Fundus photo
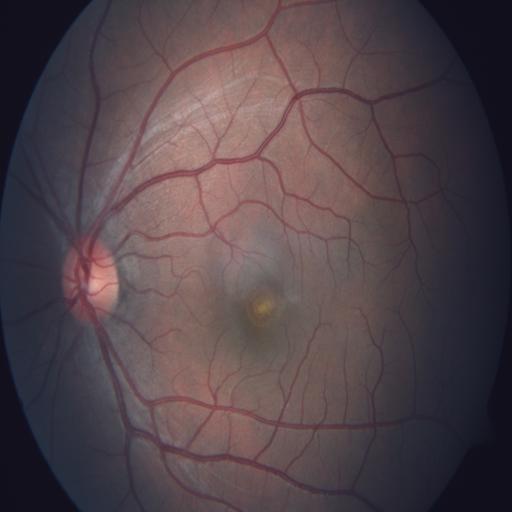 Showing chorioretinitis and choroidal folds.